Color fundus photograph.
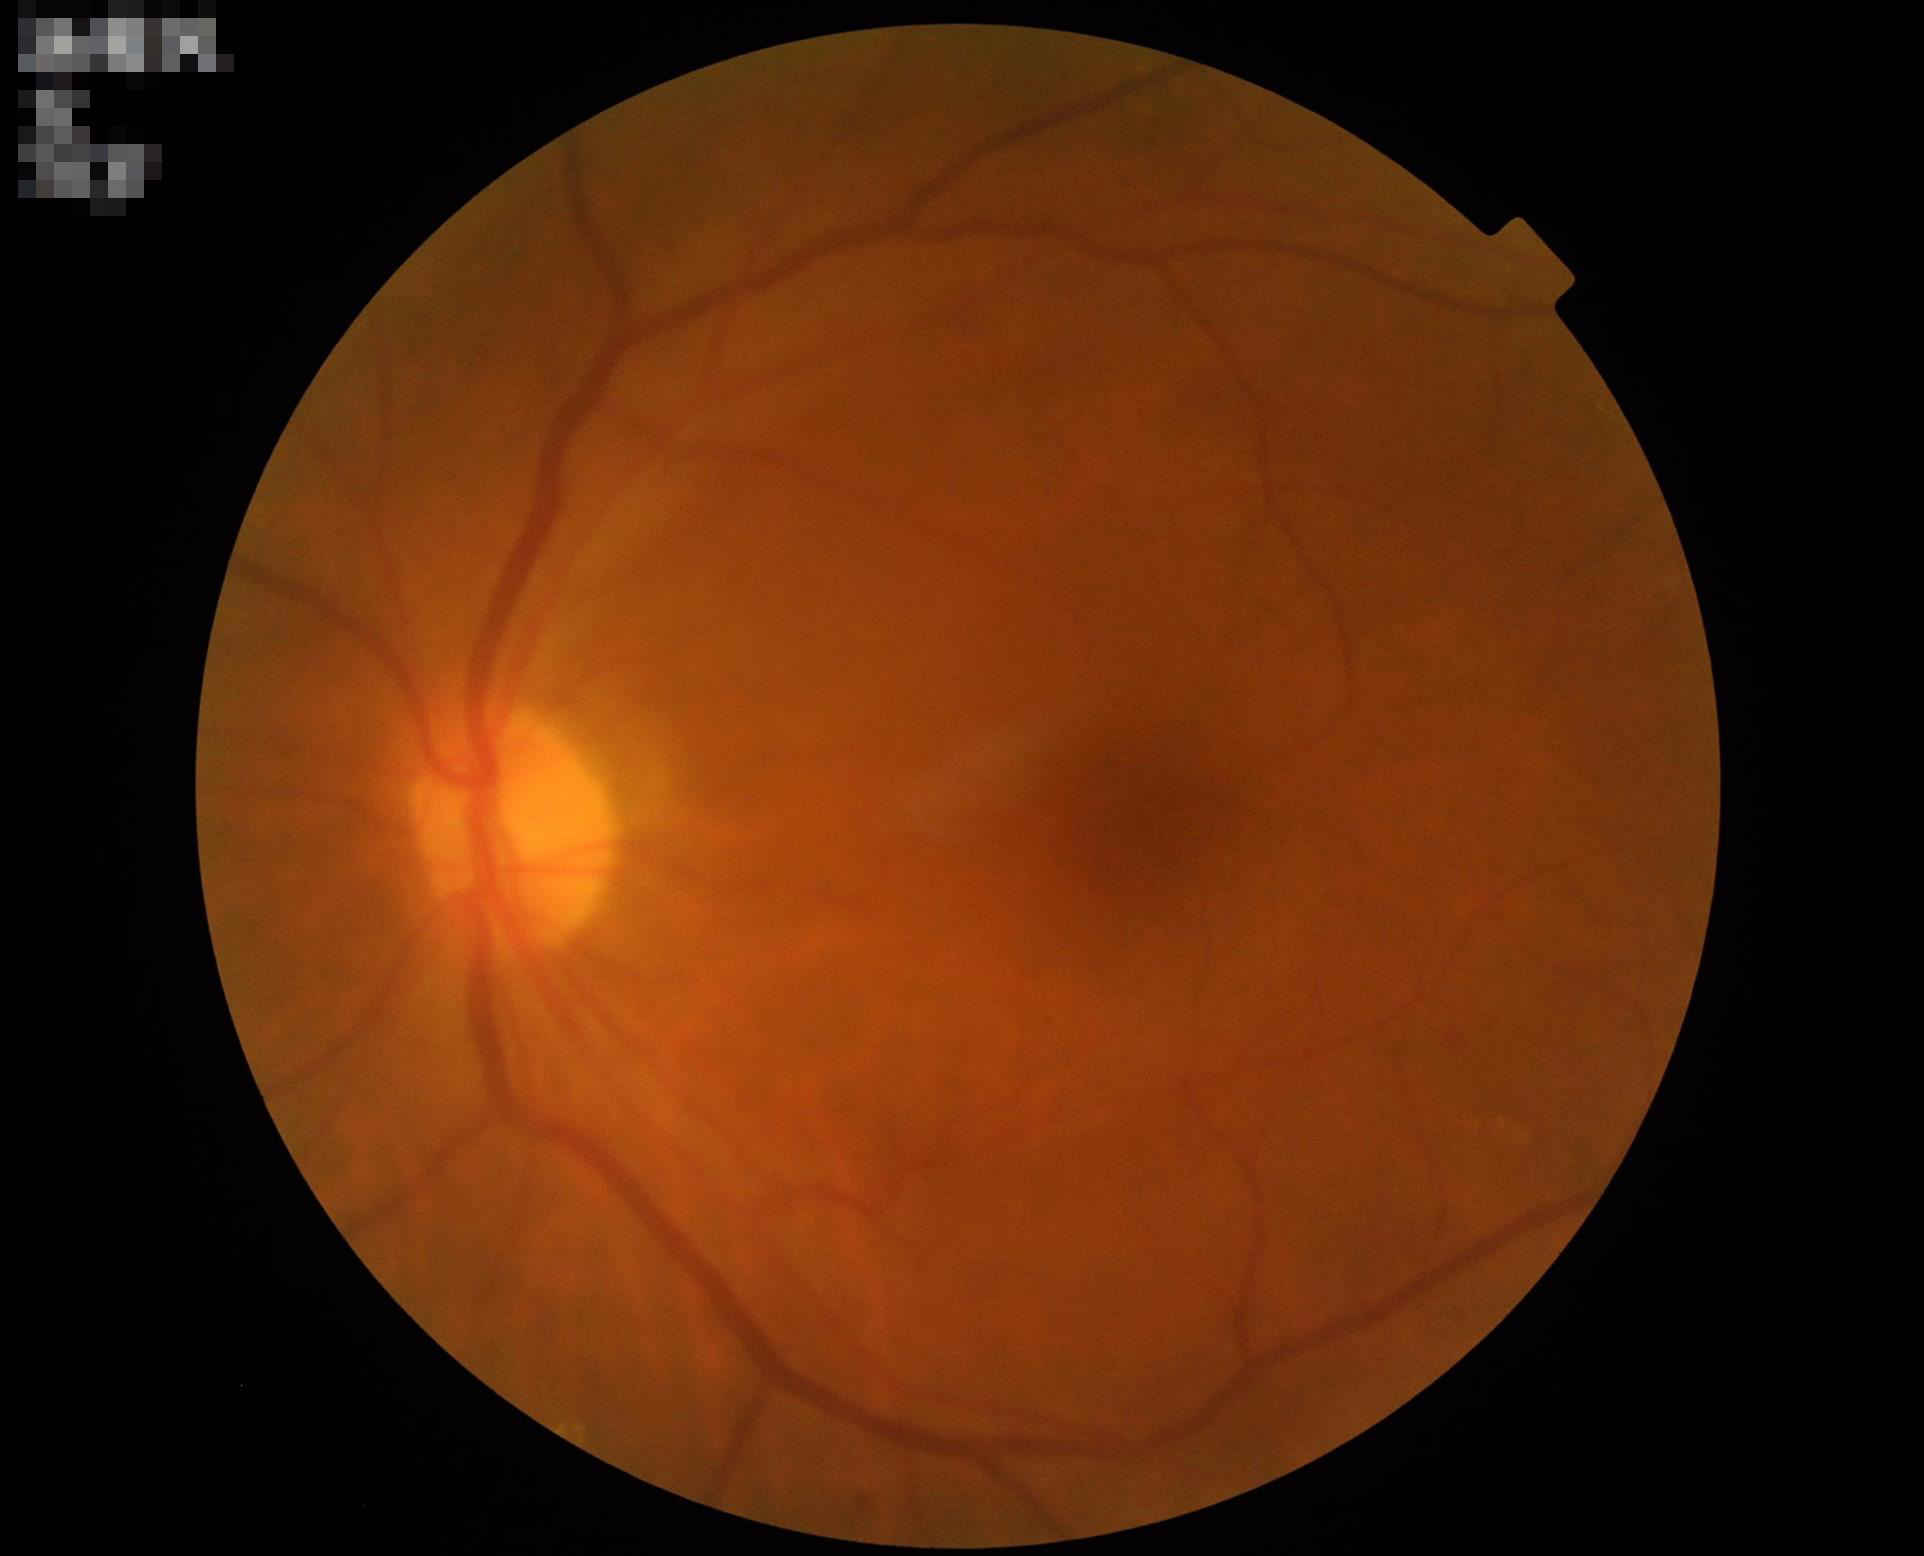 Clarity = clear
Contrast = satisfactory
Overall quality = good
Illumination/color = adequate